1932 by 1910 pixels. FOV: 45 degrees. Color fundus image
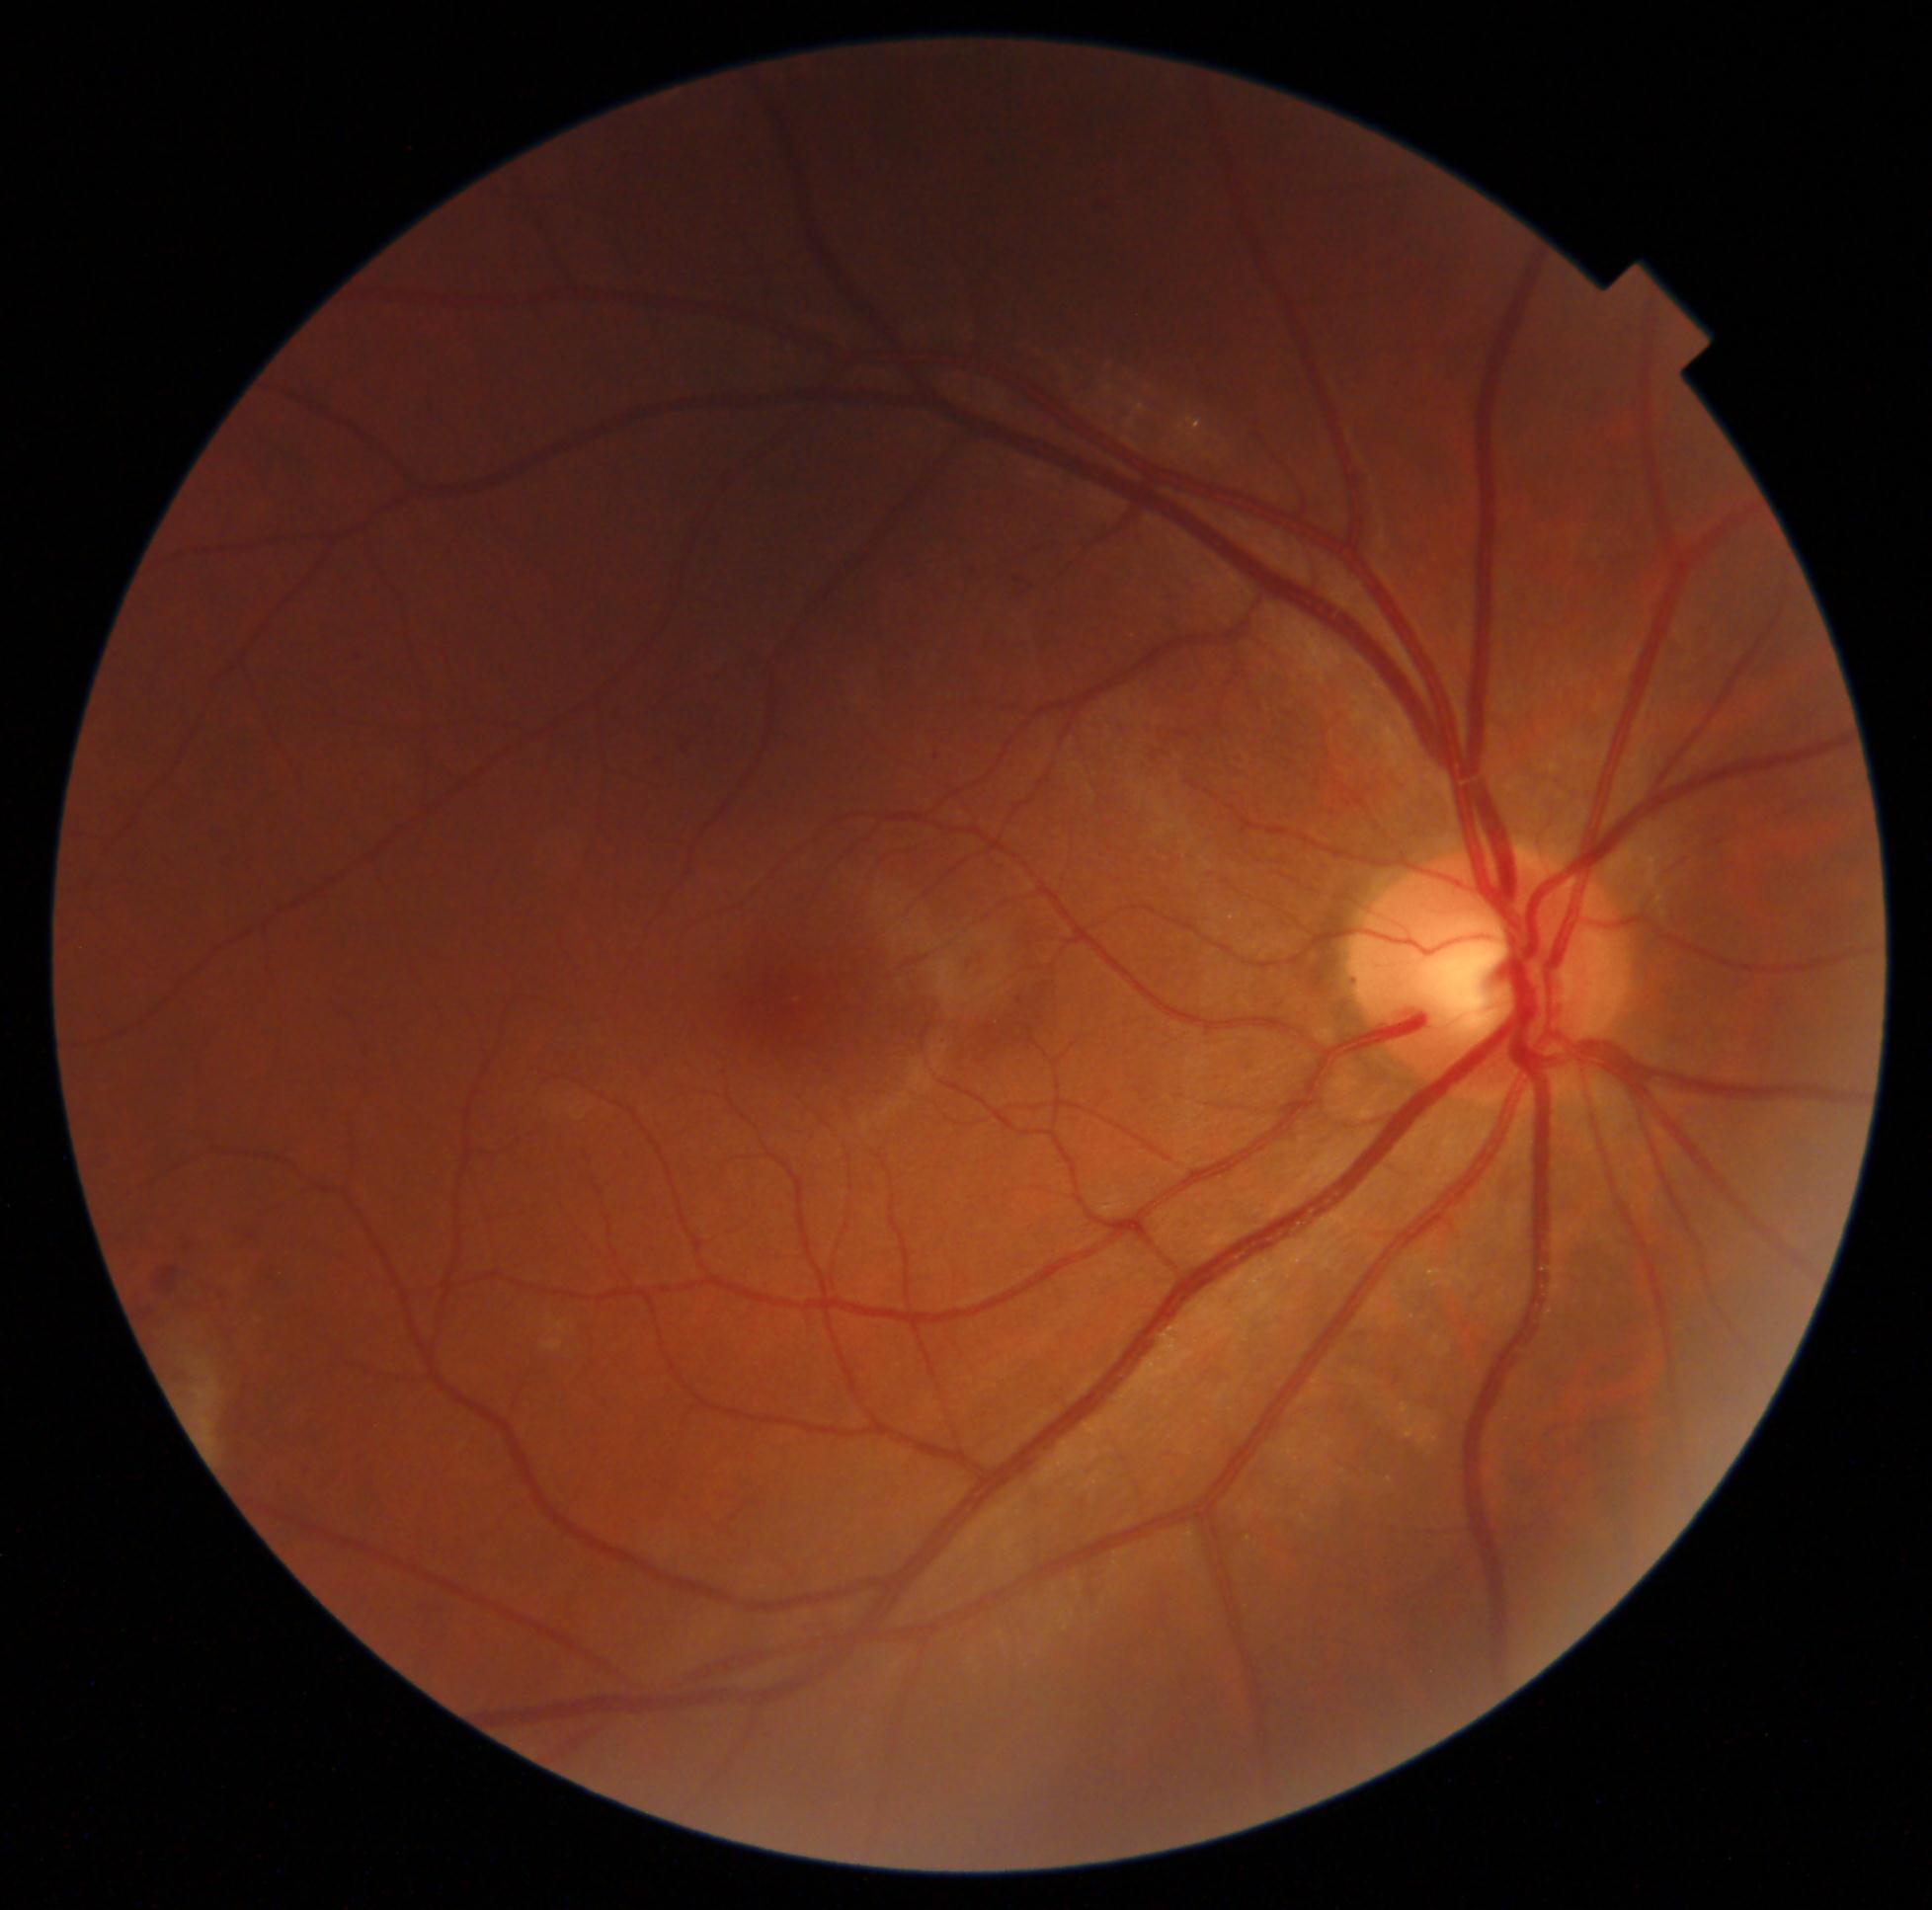
DR class=non-proliferative diabetic retinopathy, diabetic retinopathy (DR)=2/4.